CFP. Image size 1920x1440:
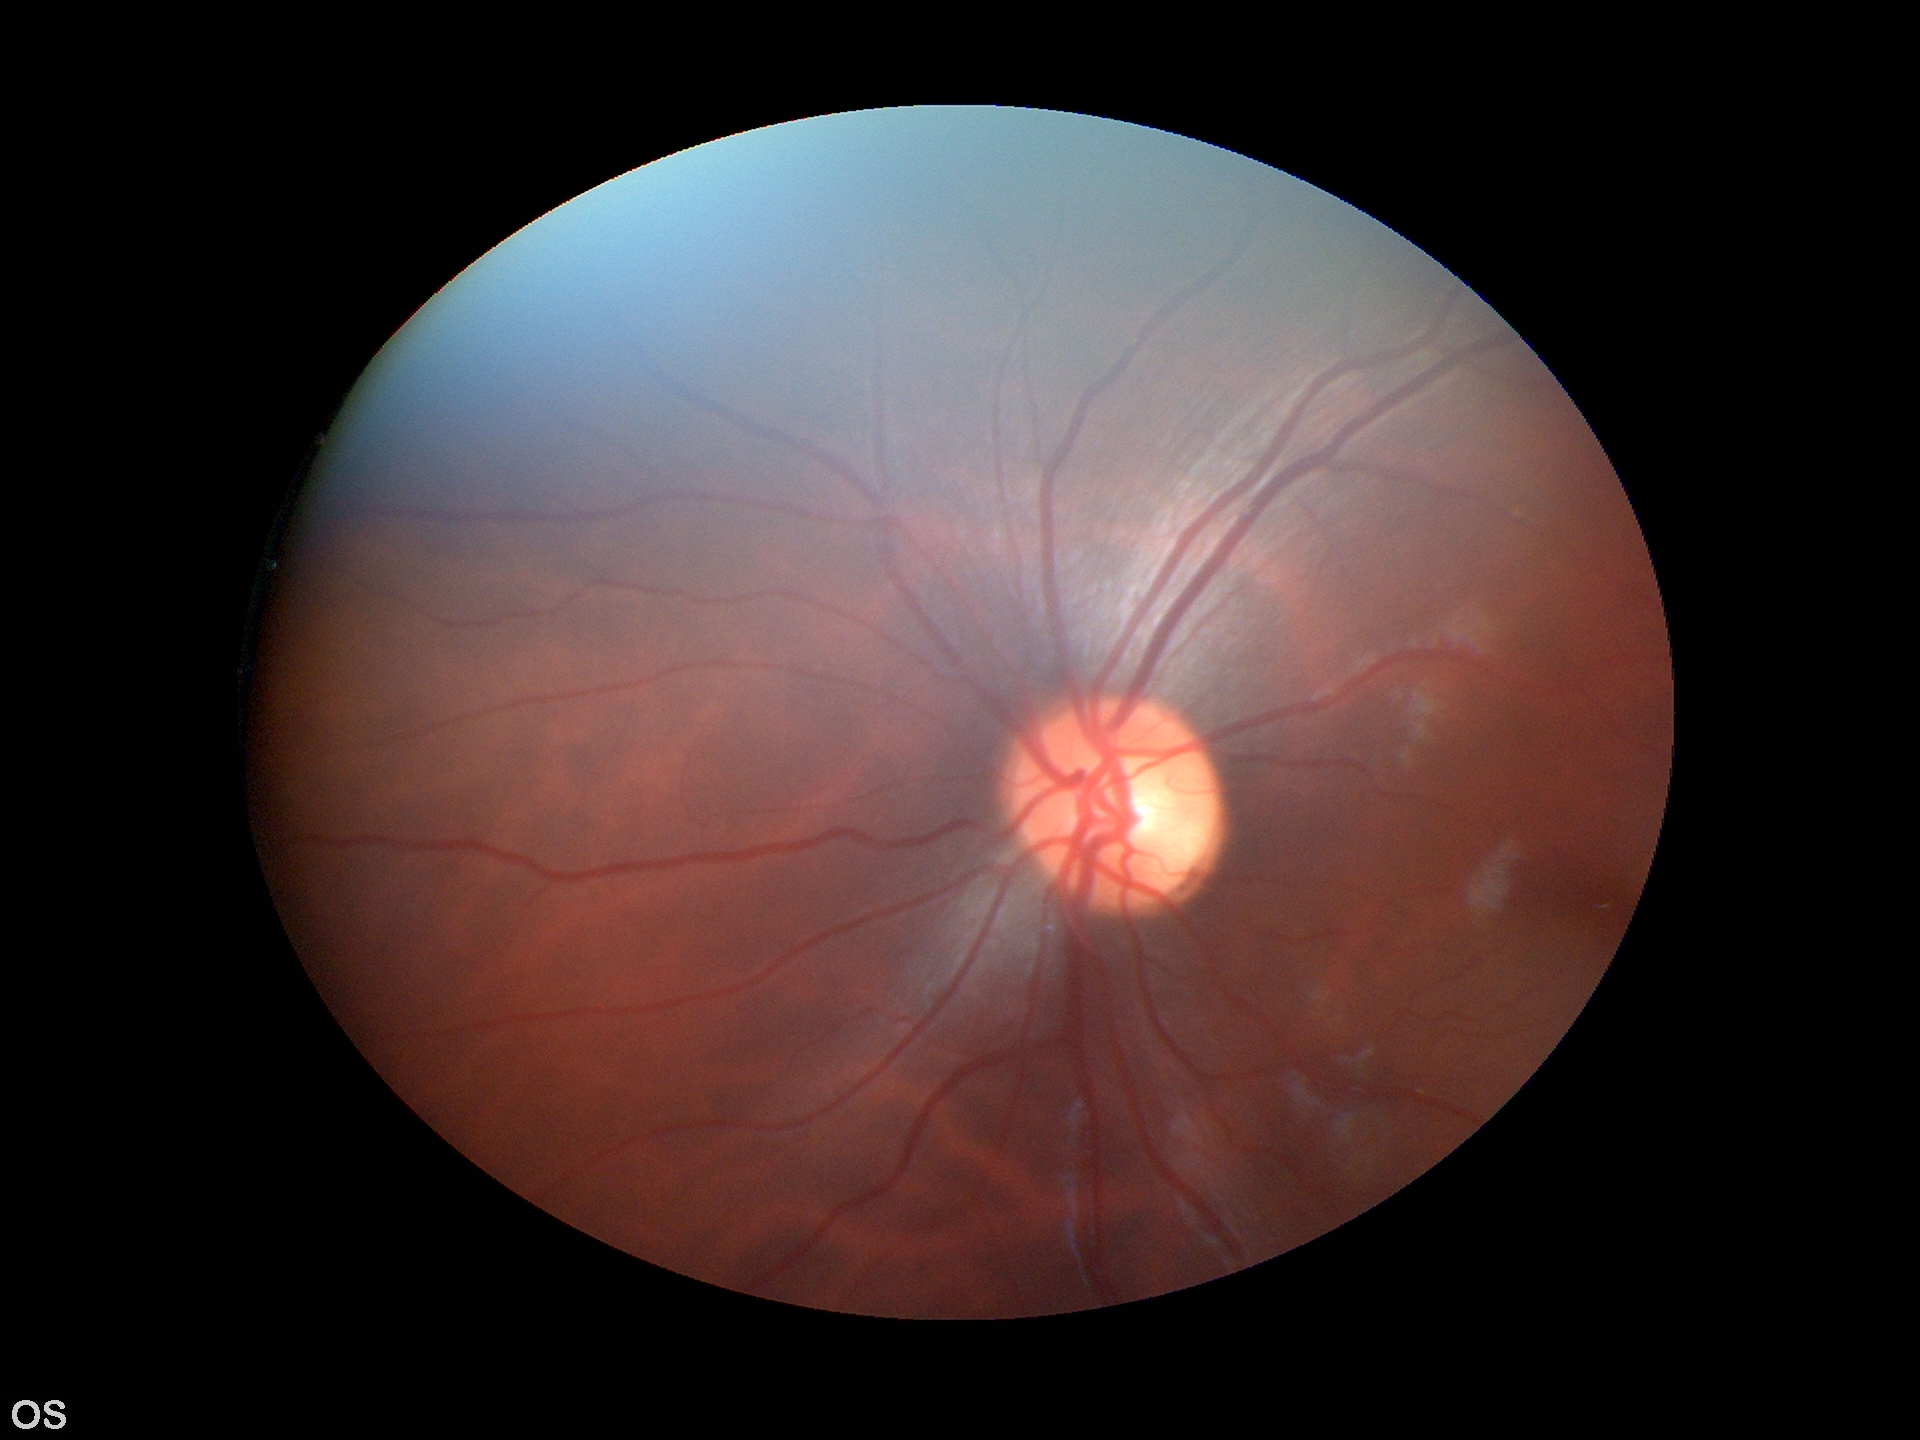 Horizontal CDR (HCDR): 0.47.
Area cup-to-disc ratio (ACDR): 0.24.
Vertical cup-to-disc ratio (VCDR) of 0.50.
No evidence of glaucoma.